1932x1932.
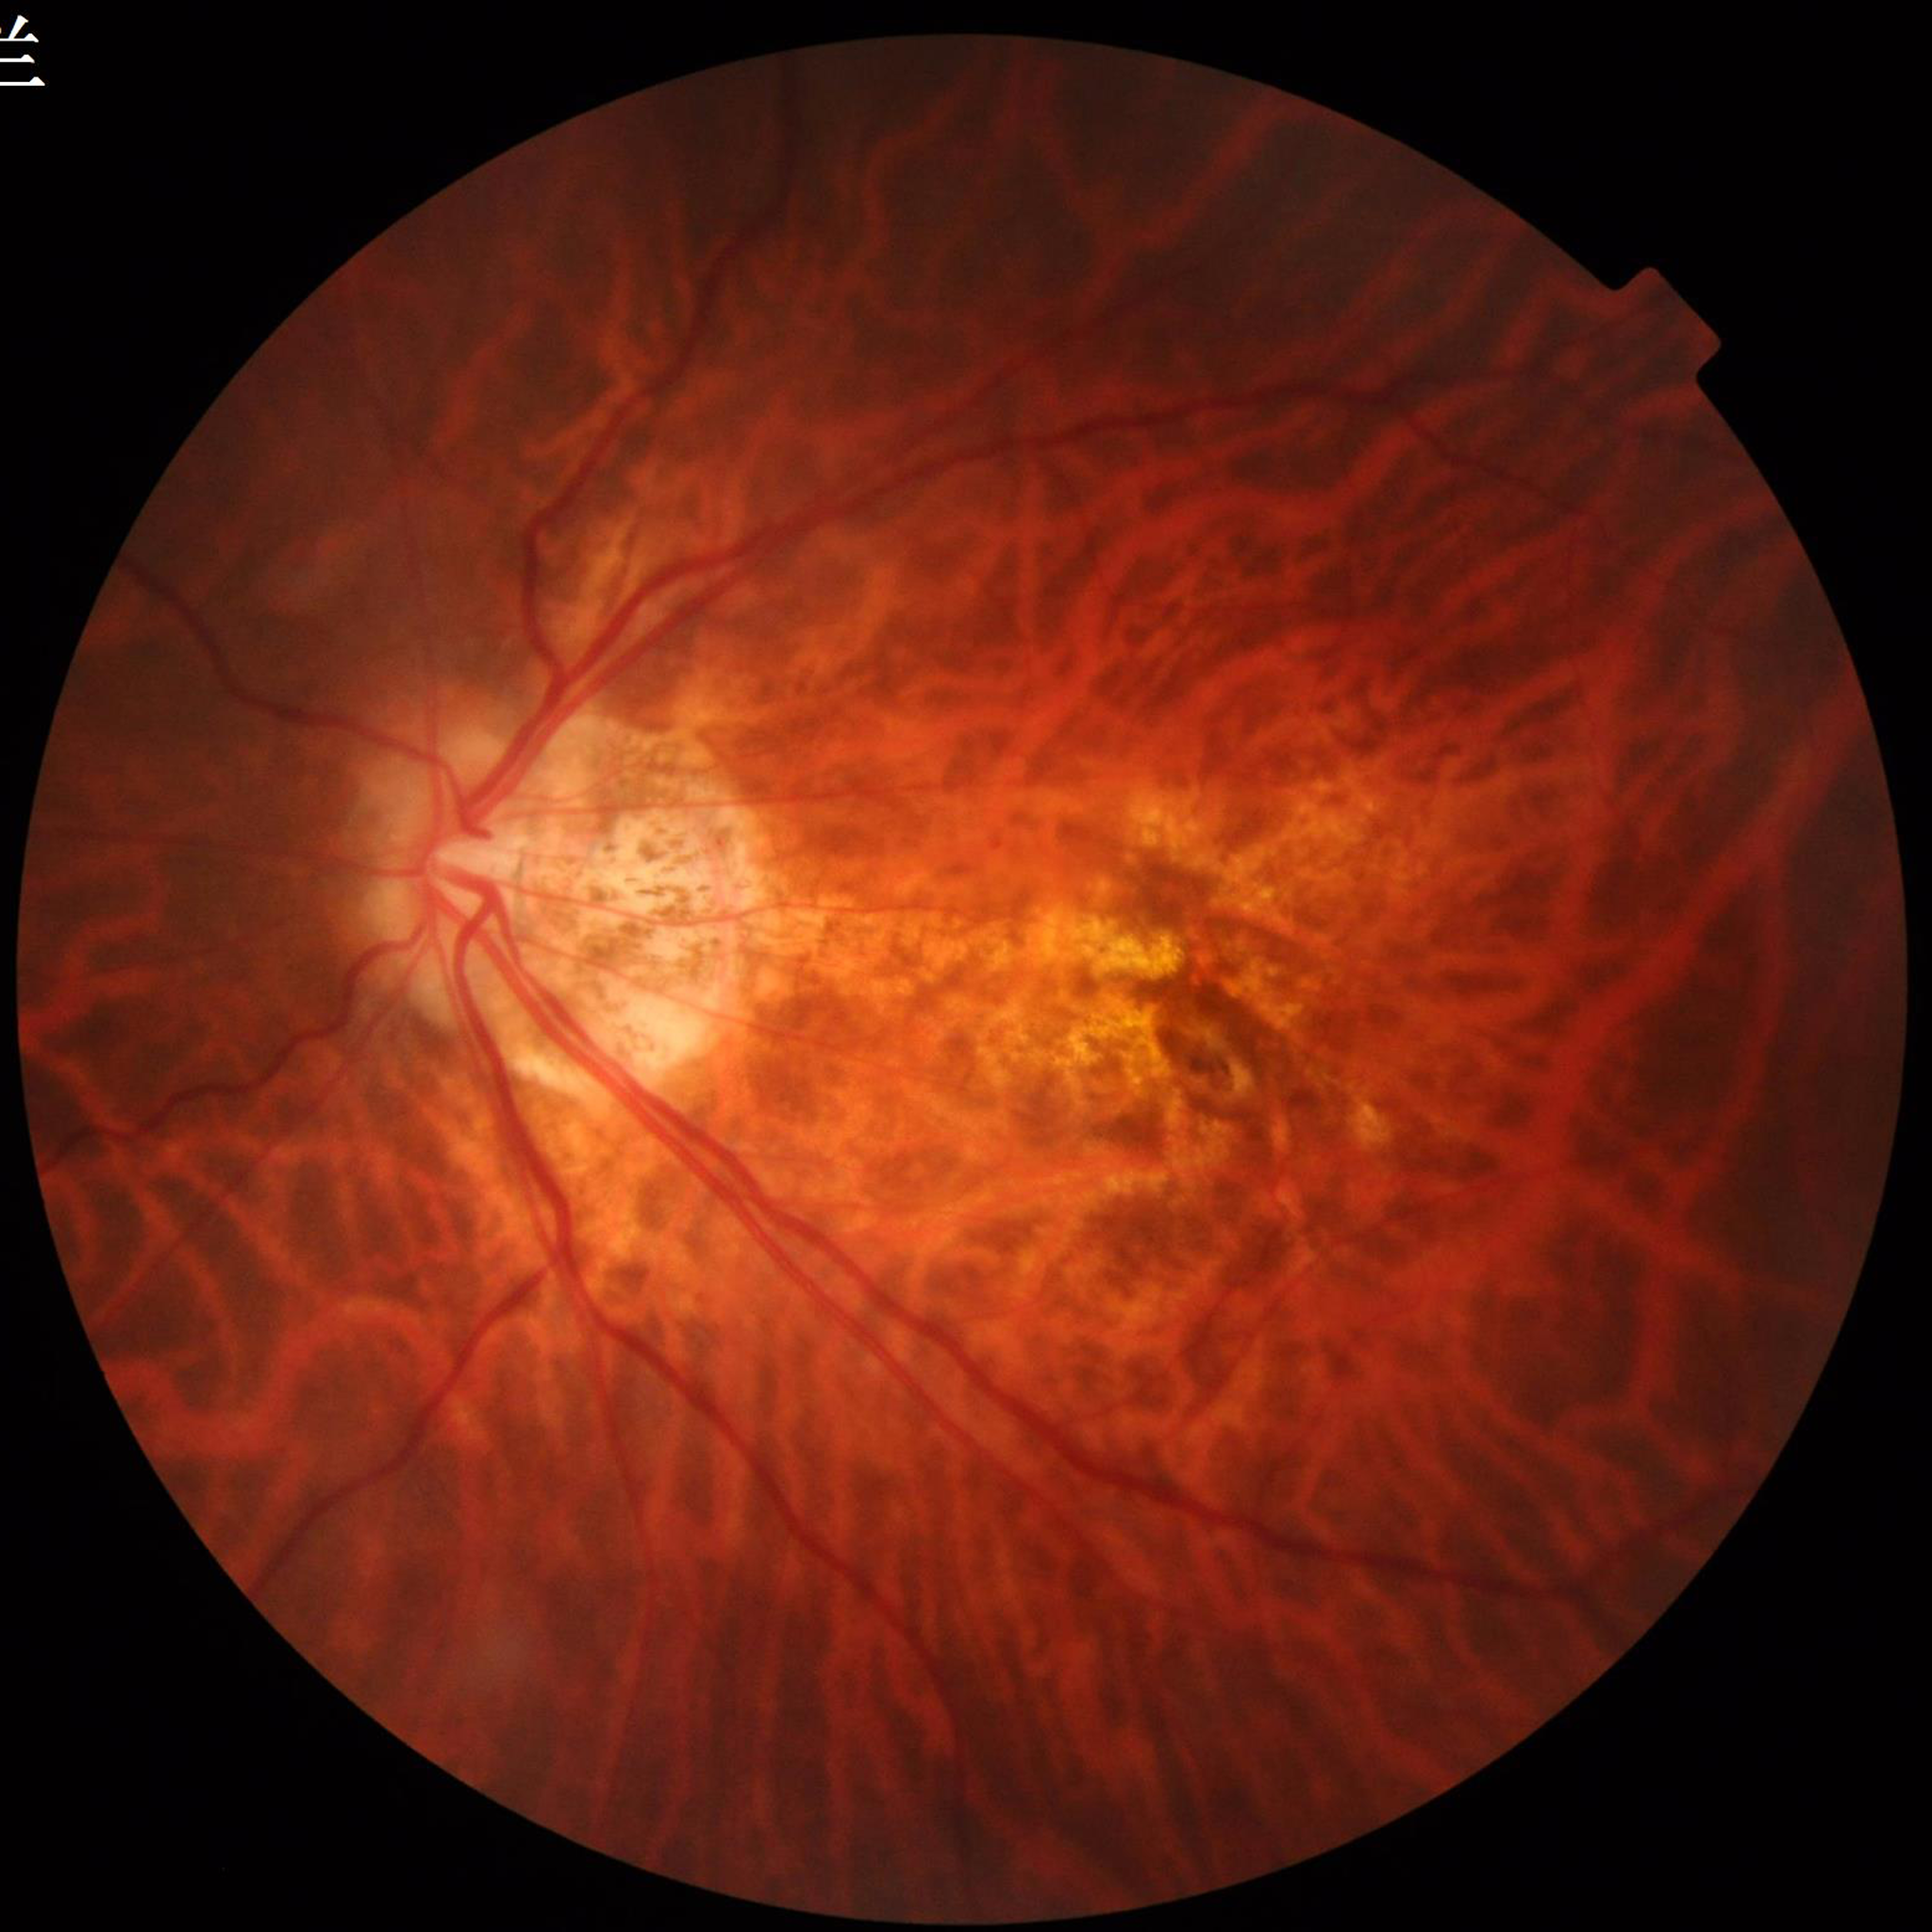 Color fundus photograph from a patient diagnosed with AMD.